Diabetic retinopathy graded by the modified Davis classification: 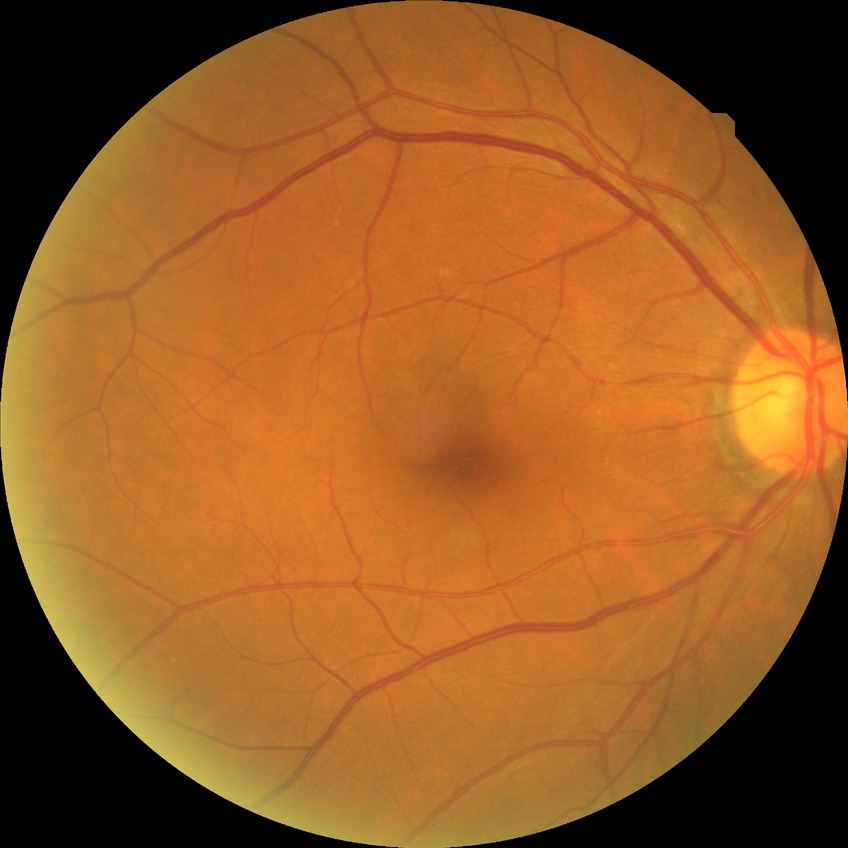

Diabetic retinopathy (DR): NDR (no diabetic retinopathy).